Wide-field contact fundus photograph of an infant — 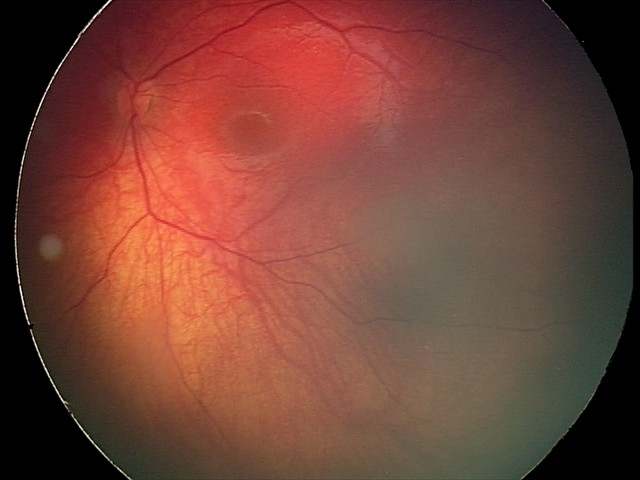 Impression = retinal astrocytic hamartoma.